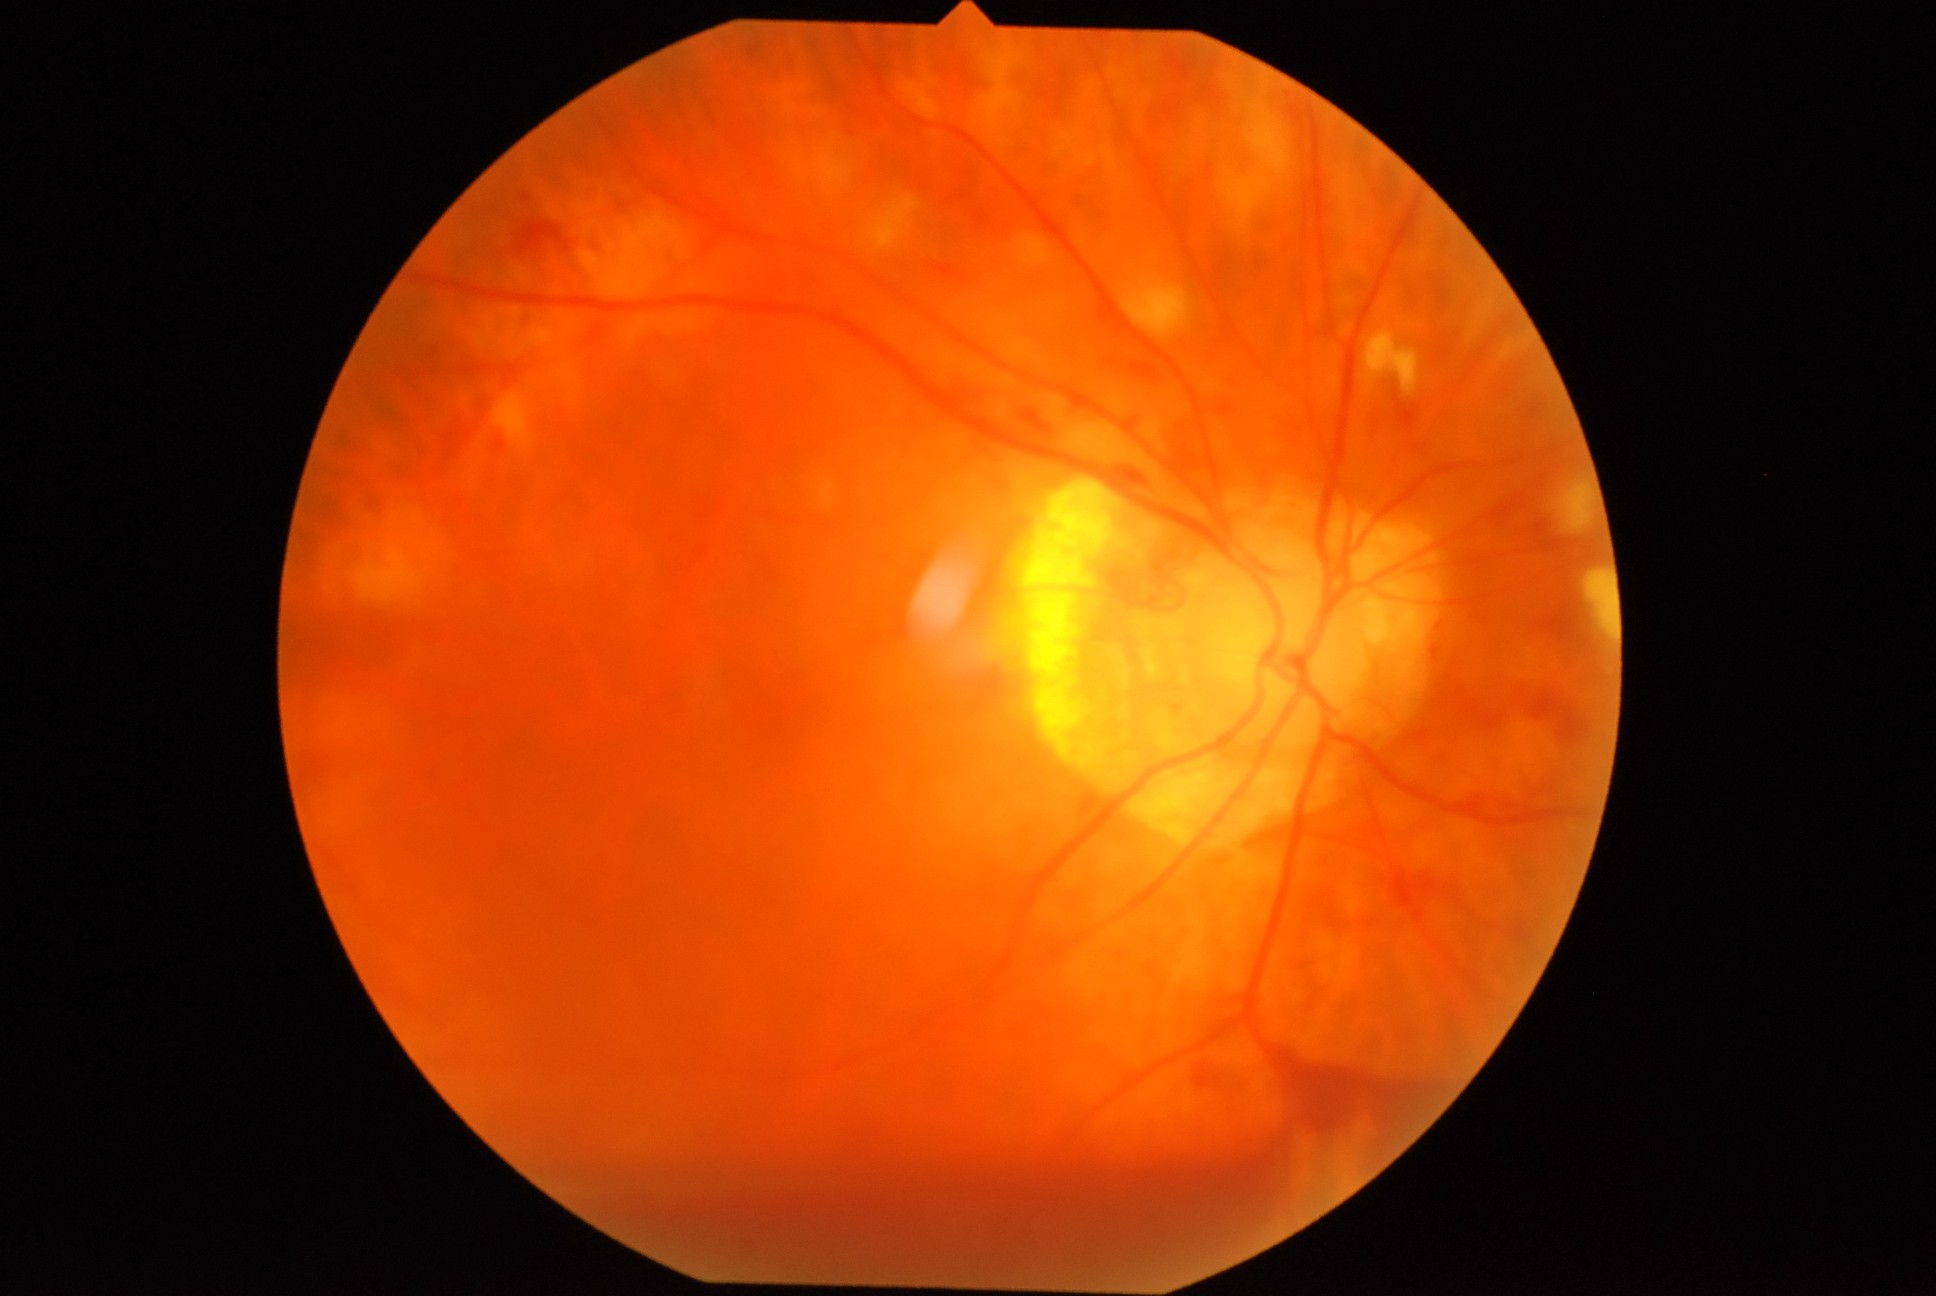

Retinopathy: 4
hard exudates: none detected
soft exudates: rect(1366, 330, 1420, 396) | rect(1587, 571, 1616, 642) | rect(1555, 483, 1595, 531) | rect(871, 196, 922, 252) | rect(1125, 281, 1192, 338) | rect(1014, 234, 1055, 267)
microaneurysms: none detected
hemorrhages: rect(1164, 109, 1175, 122) | rect(1264, 1039, 1456, 1176) | rect(1395, 404, 1420, 429) | rect(1289, 105, 1306, 139) | rect(520, 1117, 1304, 1288) | rect(1450, 686, 1516, 734) | rect(1202, 87, 1223, 113) | rect(524, 194, 531, 202) | rect(1395, 873, 1433, 908) | rect(1109, 468, 1145, 488) | rect(1133, 365, 1159, 380) | rect(1195, 1065, 1246, 1088) | rect(564, 242, 572, 252) | rect(1534, 697, 1585, 744) | rect(1168, 52, 1193, 83) | rect(1023, 410, 1048, 433) | rect(933, 264, 967, 284) | rect(518, 221, 564, 254)